Captured on a Nidek AFC-330 fundus camera: 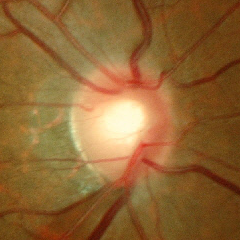 Color fundus photograph showing early glaucomatous changes.